Acquired with a Nidek AFC-330 — 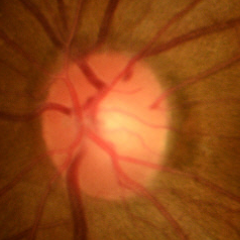

Color fundus photograph showing no signs of glaucoma.